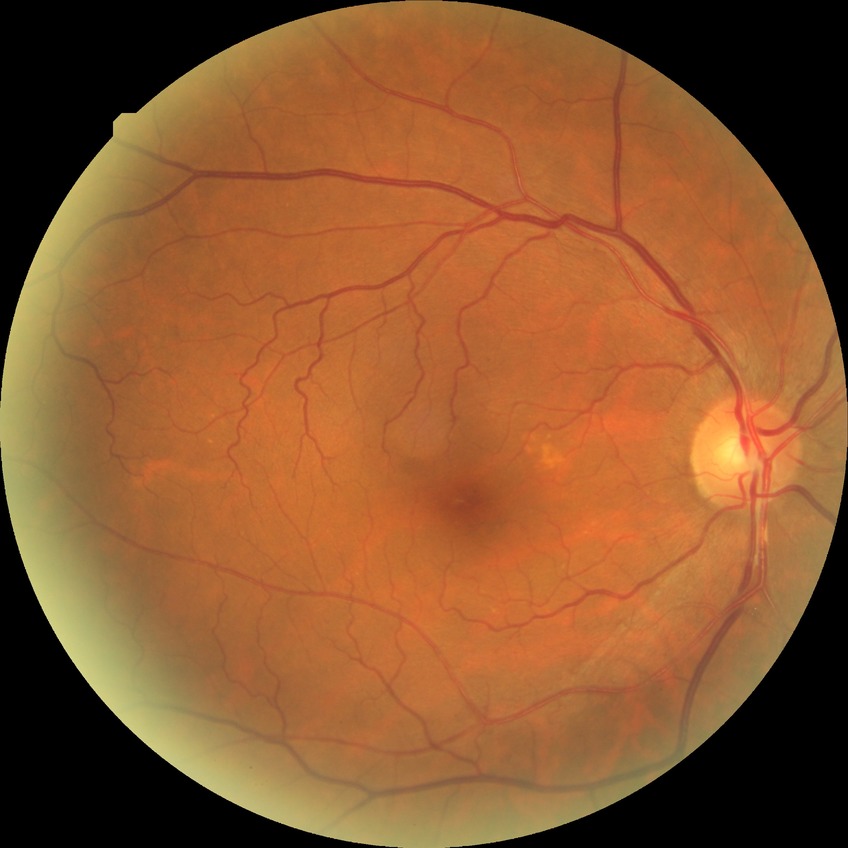 davis_grade: NDR